Nonmydriatic. Graded on the modified Davis scale. Image size 848x848:
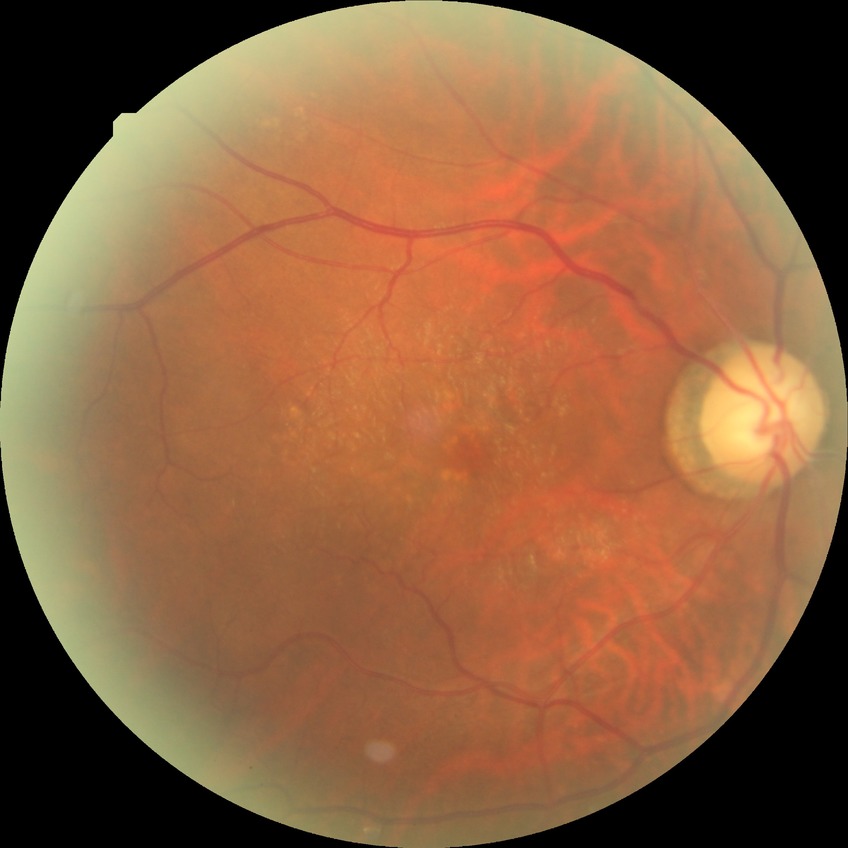
Modified Davis grading: no diabetic retinopathy.